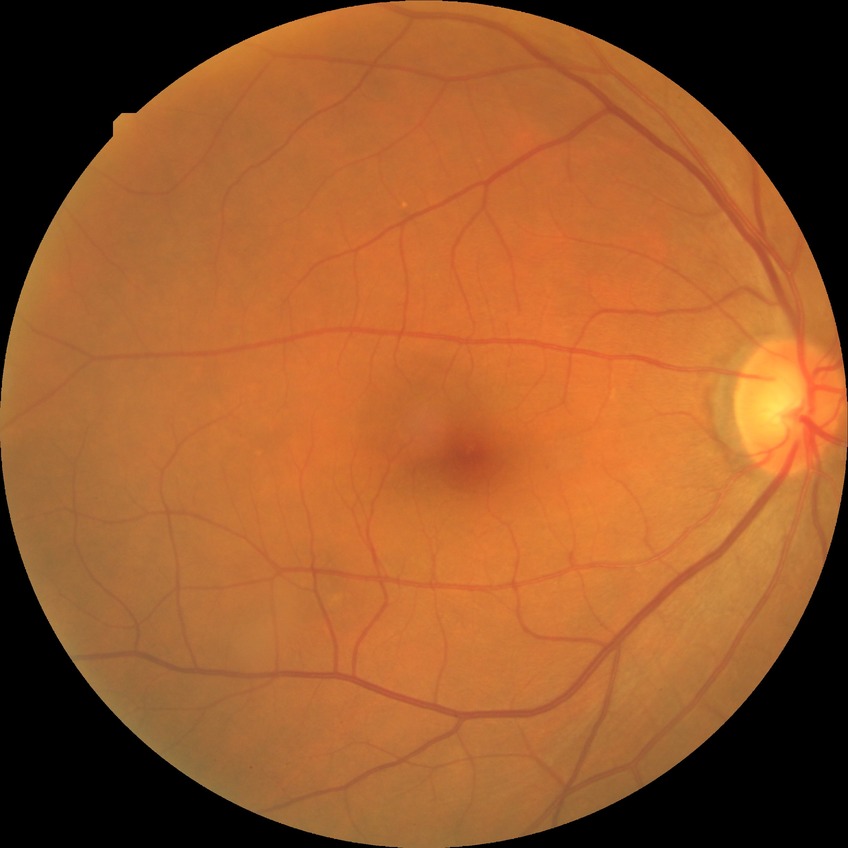

diabetic retinopathy (DR)=NDR (no diabetic retinopathy).